Wide-field contact fundus photograph of an infant. 640 x 480 pixels.
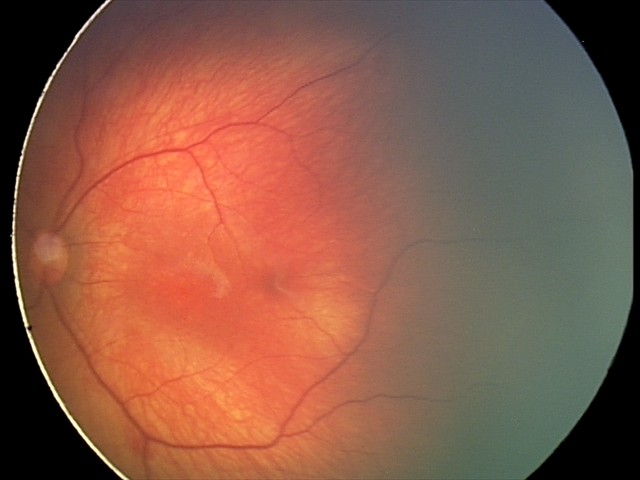

Impression = retinal hemorrhages.